Graded on the modified Davis scale, 45° FOV: 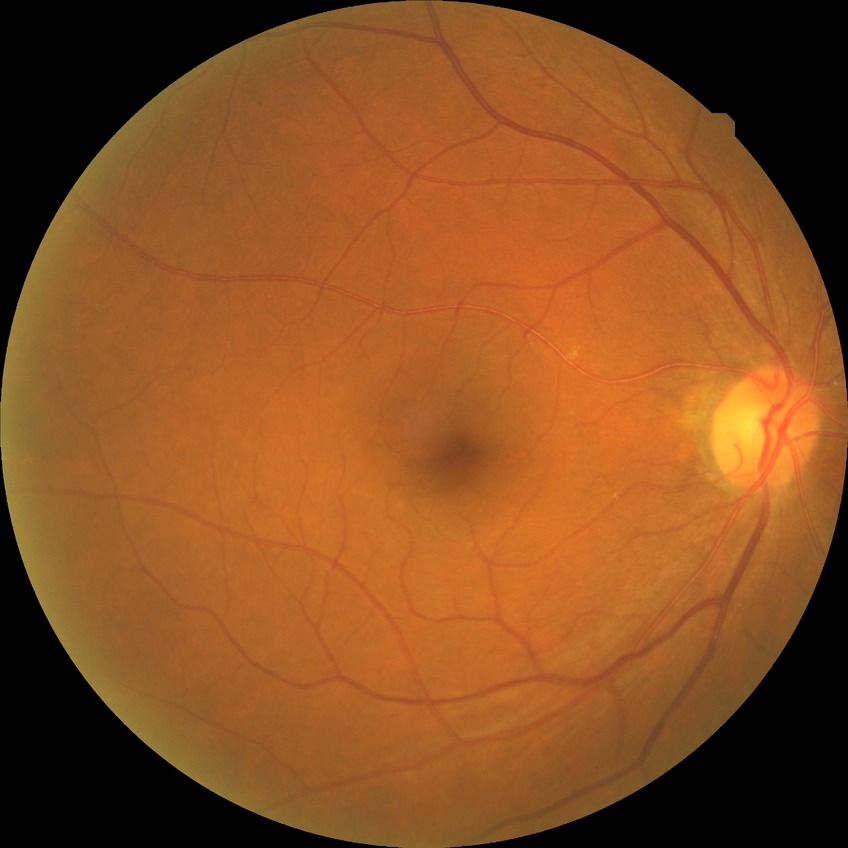
Findings:
• DR impression: no signs of DR
• DR grade: NDR